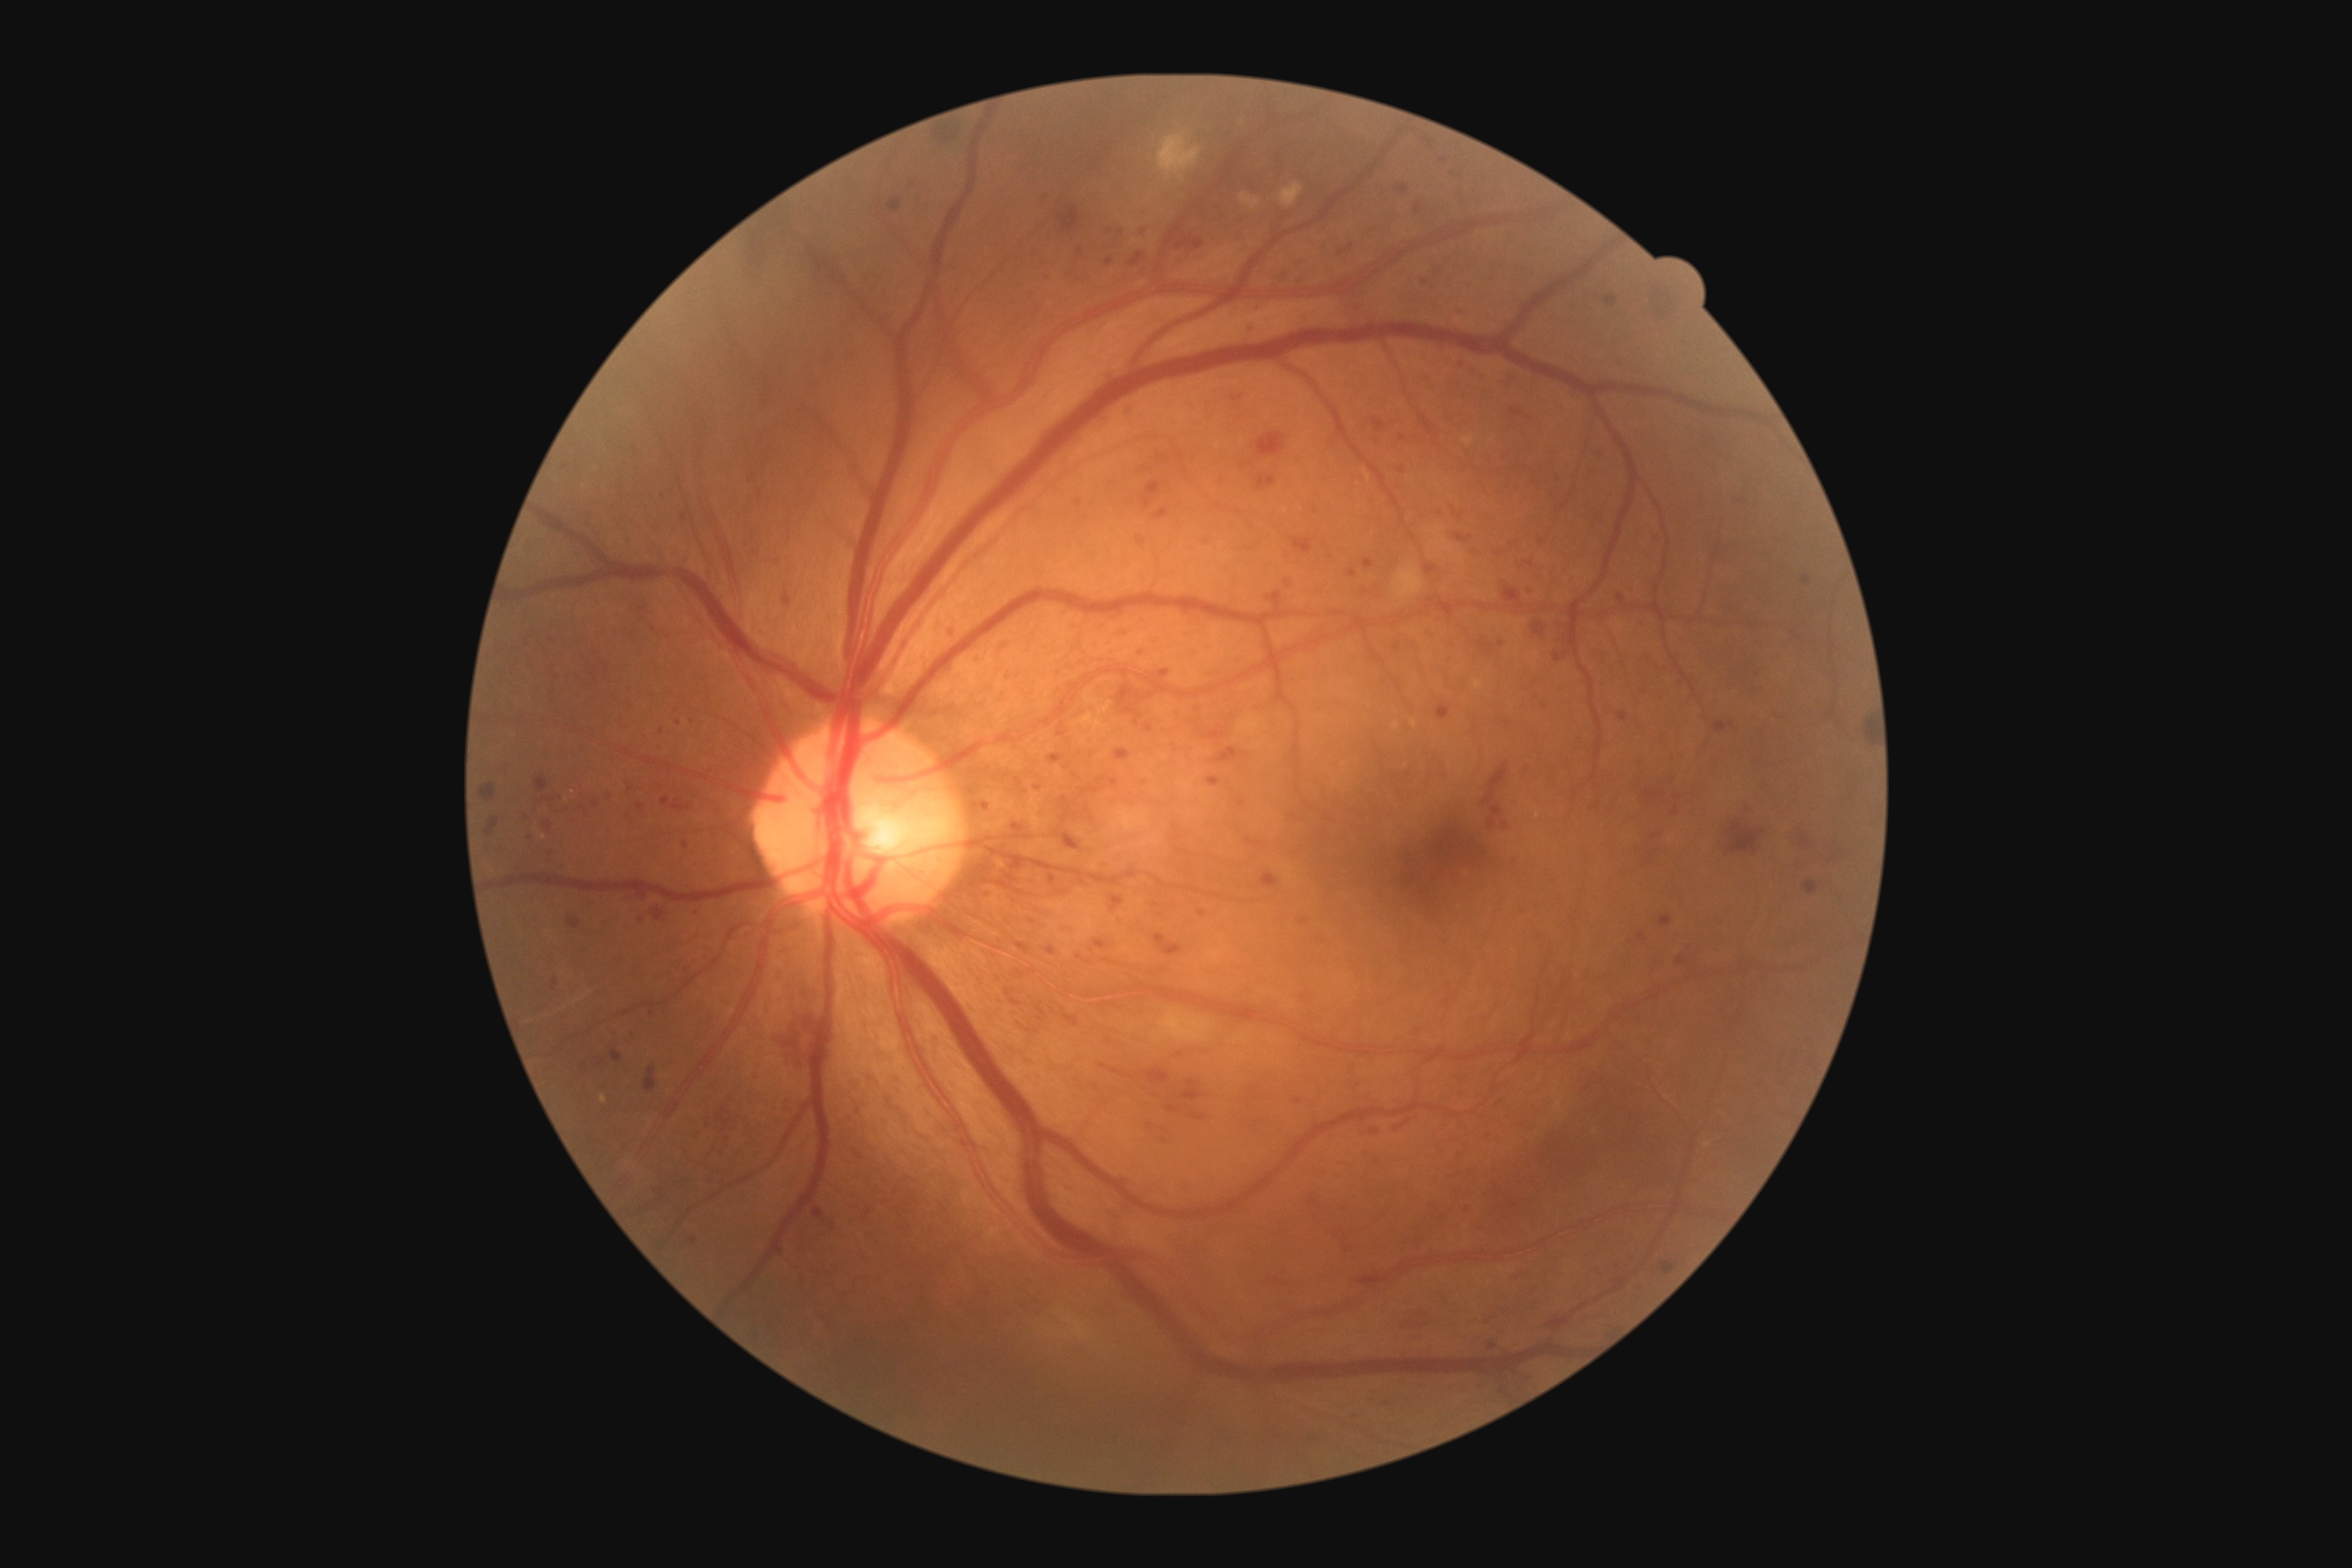
Diabetic retinopathy severity: grade 3 (severe NPDR).